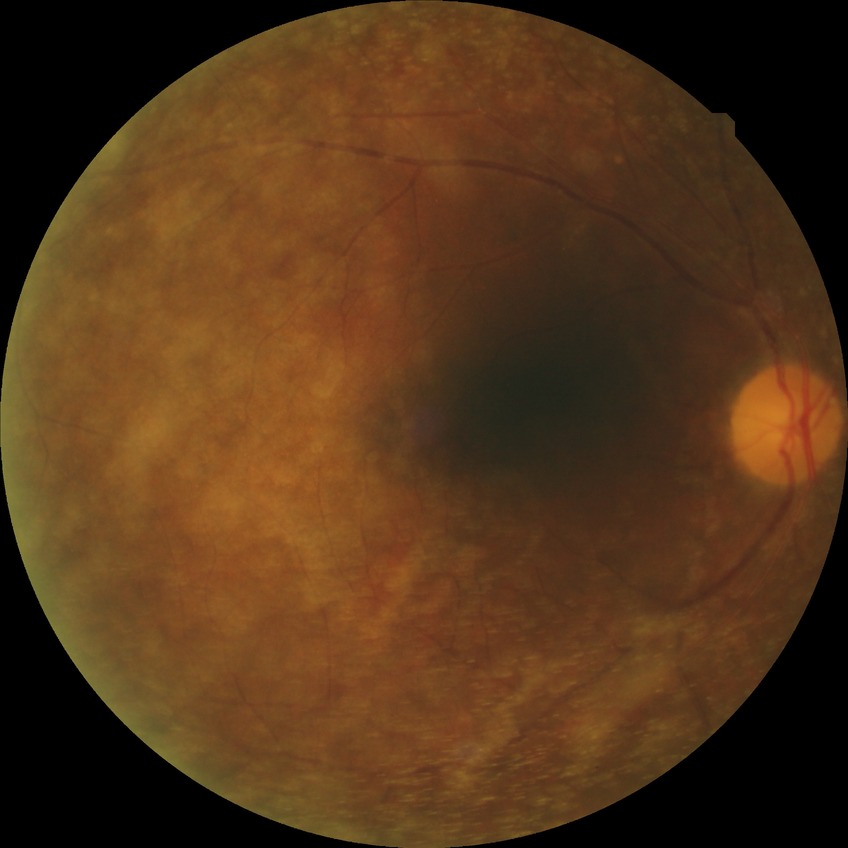 Diabetic retinopathy stage: no diabetic retinopathy.